Color fundus image, 45-degree field of view — 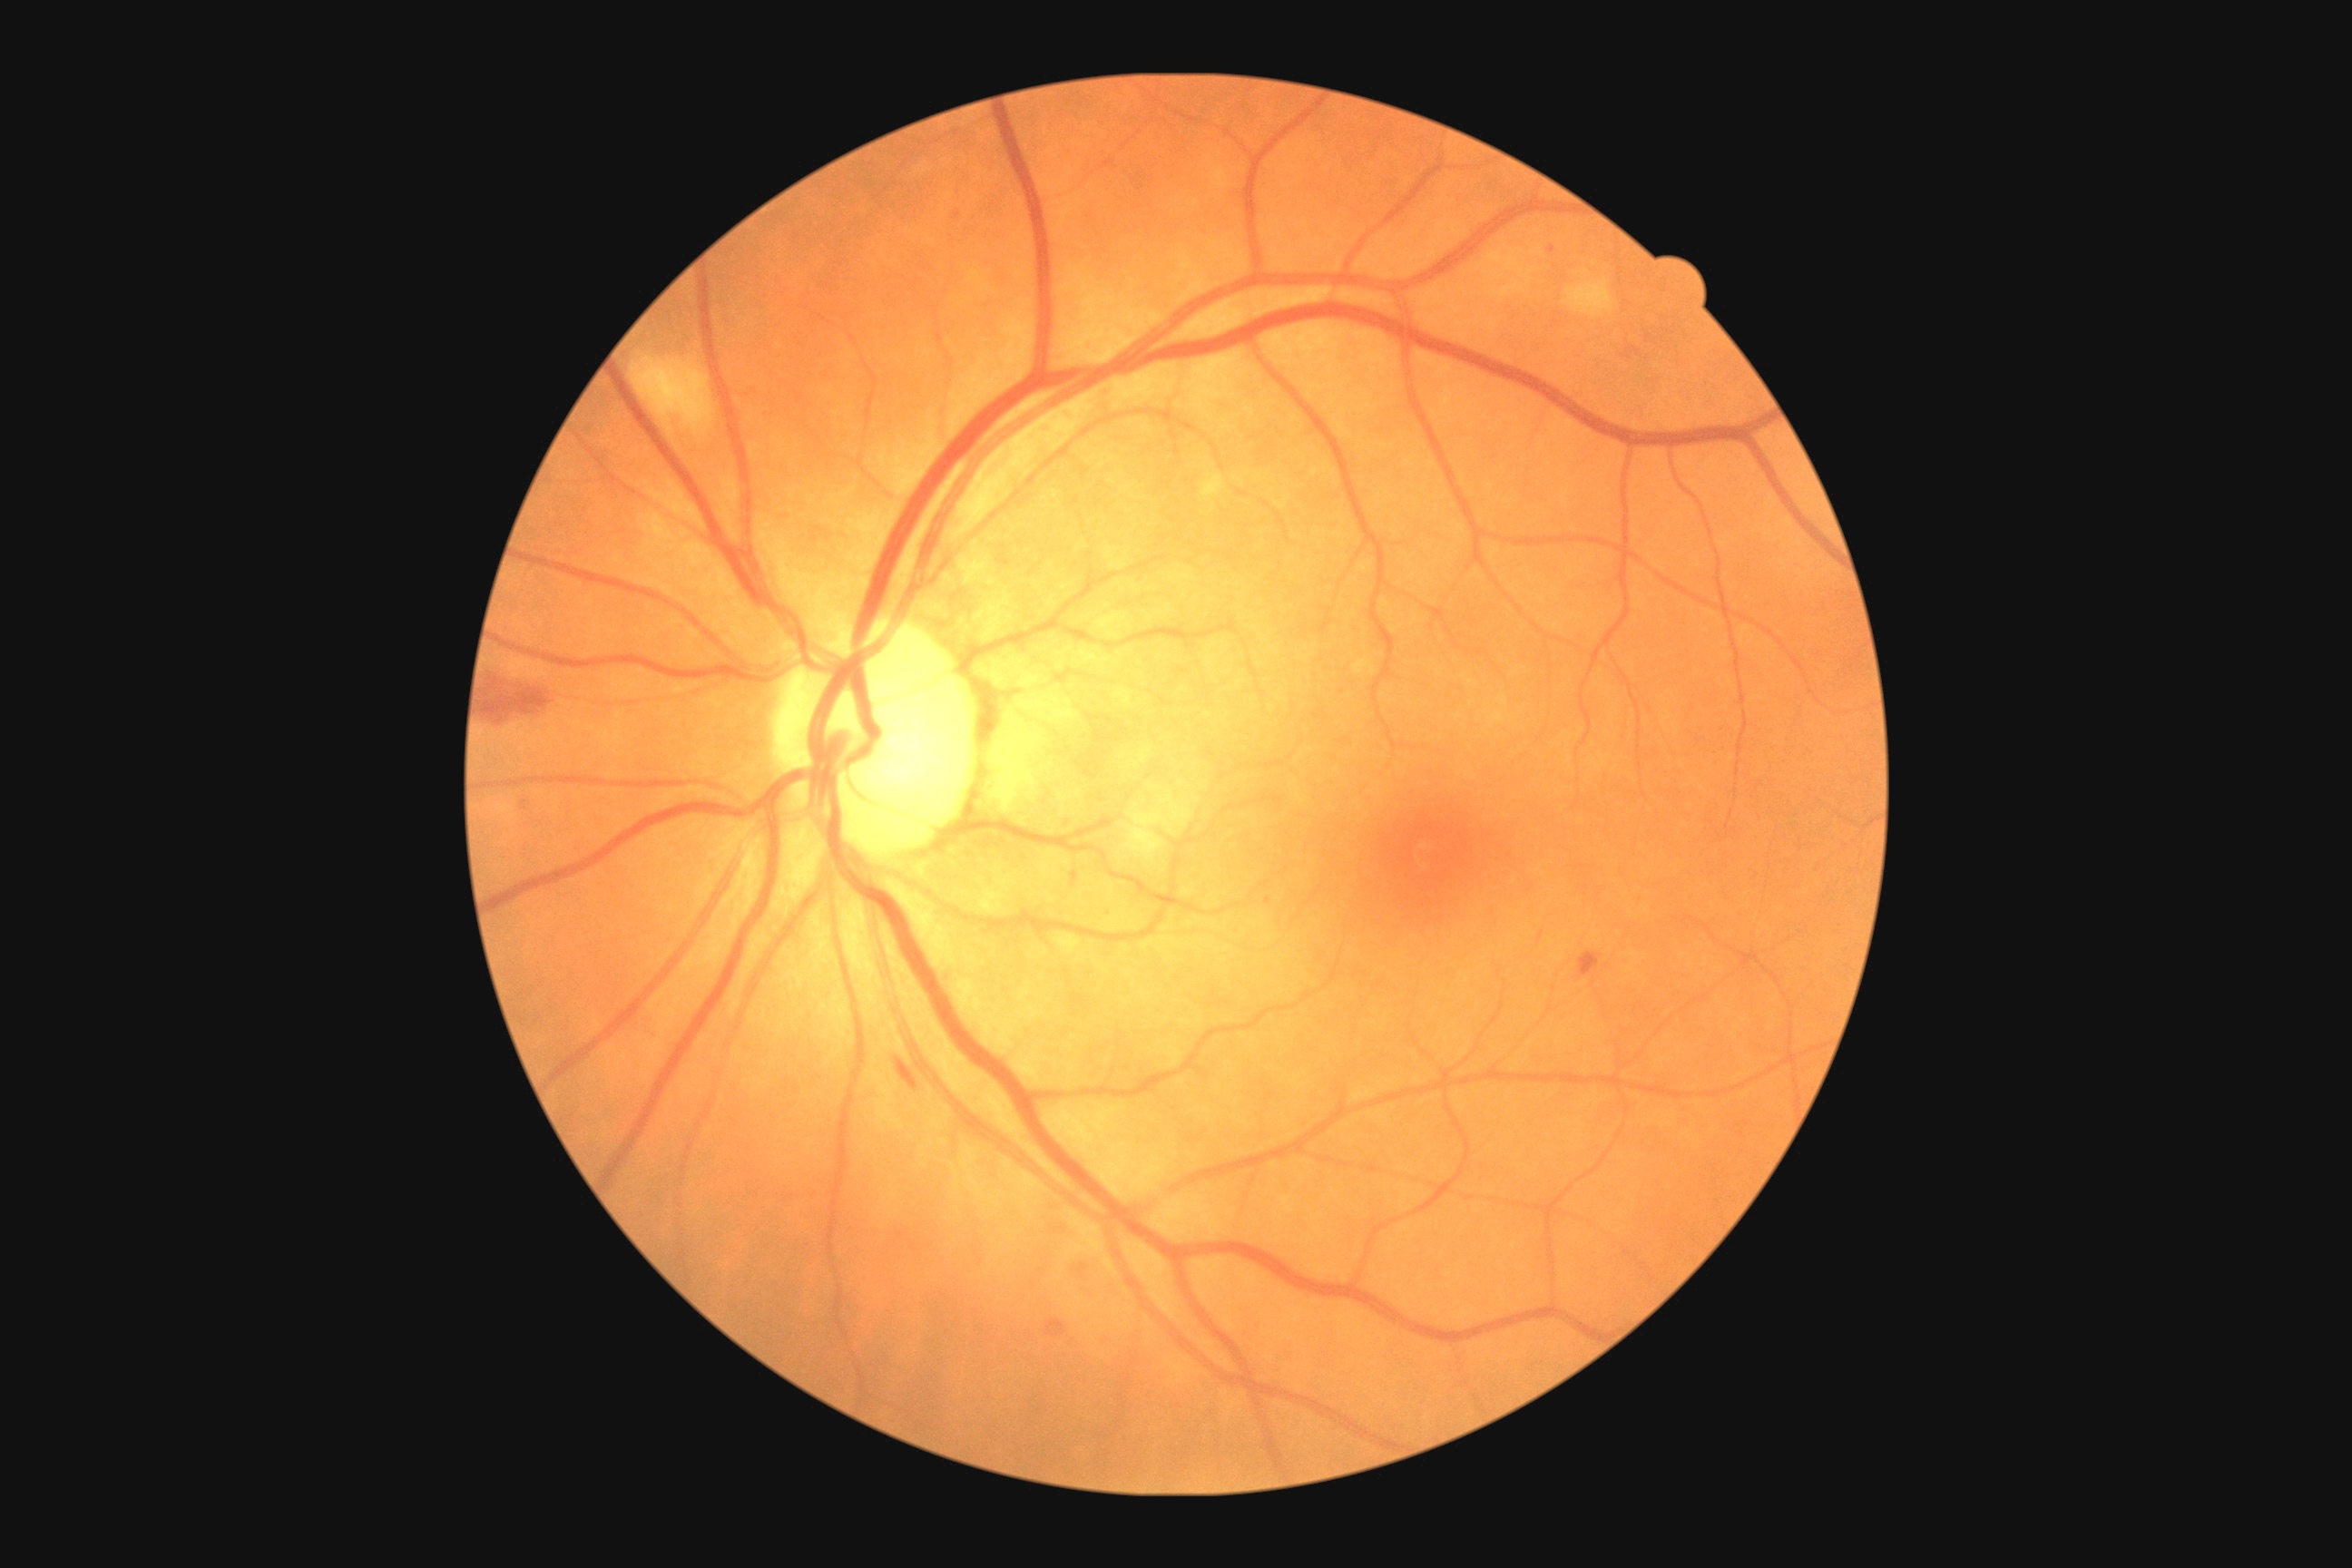 diabetic retinopathy severity@2/4.